Non-mydriatic acquisition:
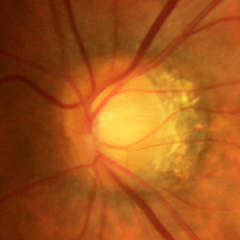
Findings consistent with early glaucomatous optic neuropathy.